Nonmydriatic; image size 848x848; 45-degree field of view; fundus photo:
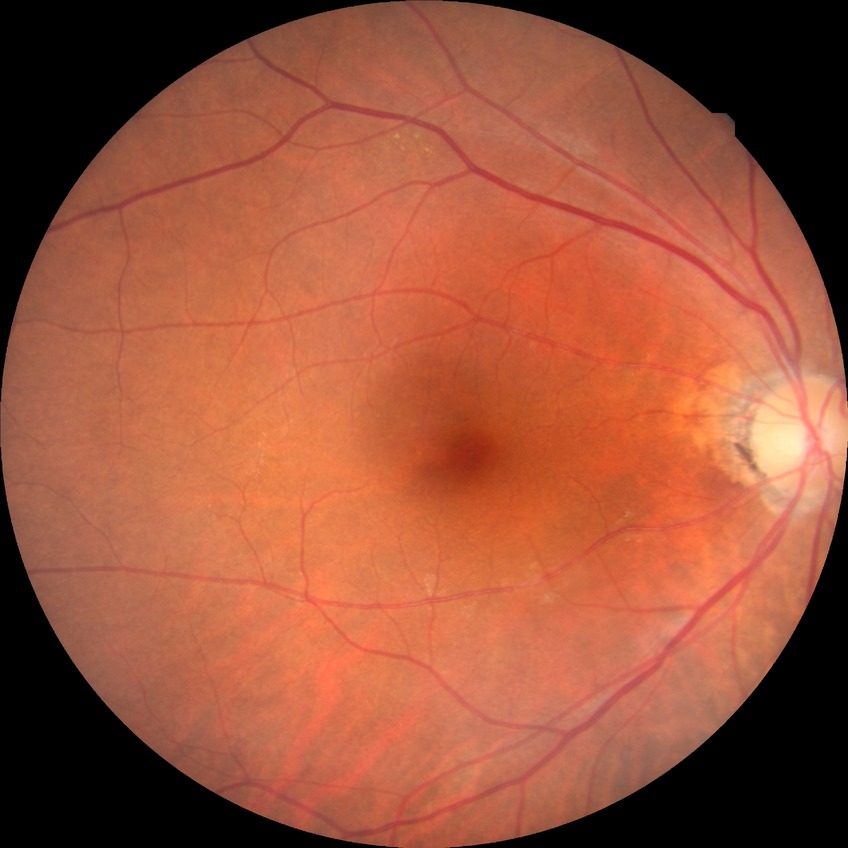

Diabetic retinopathy (DR) is SDR (simple diabetic retinopathy).